2048x1536:
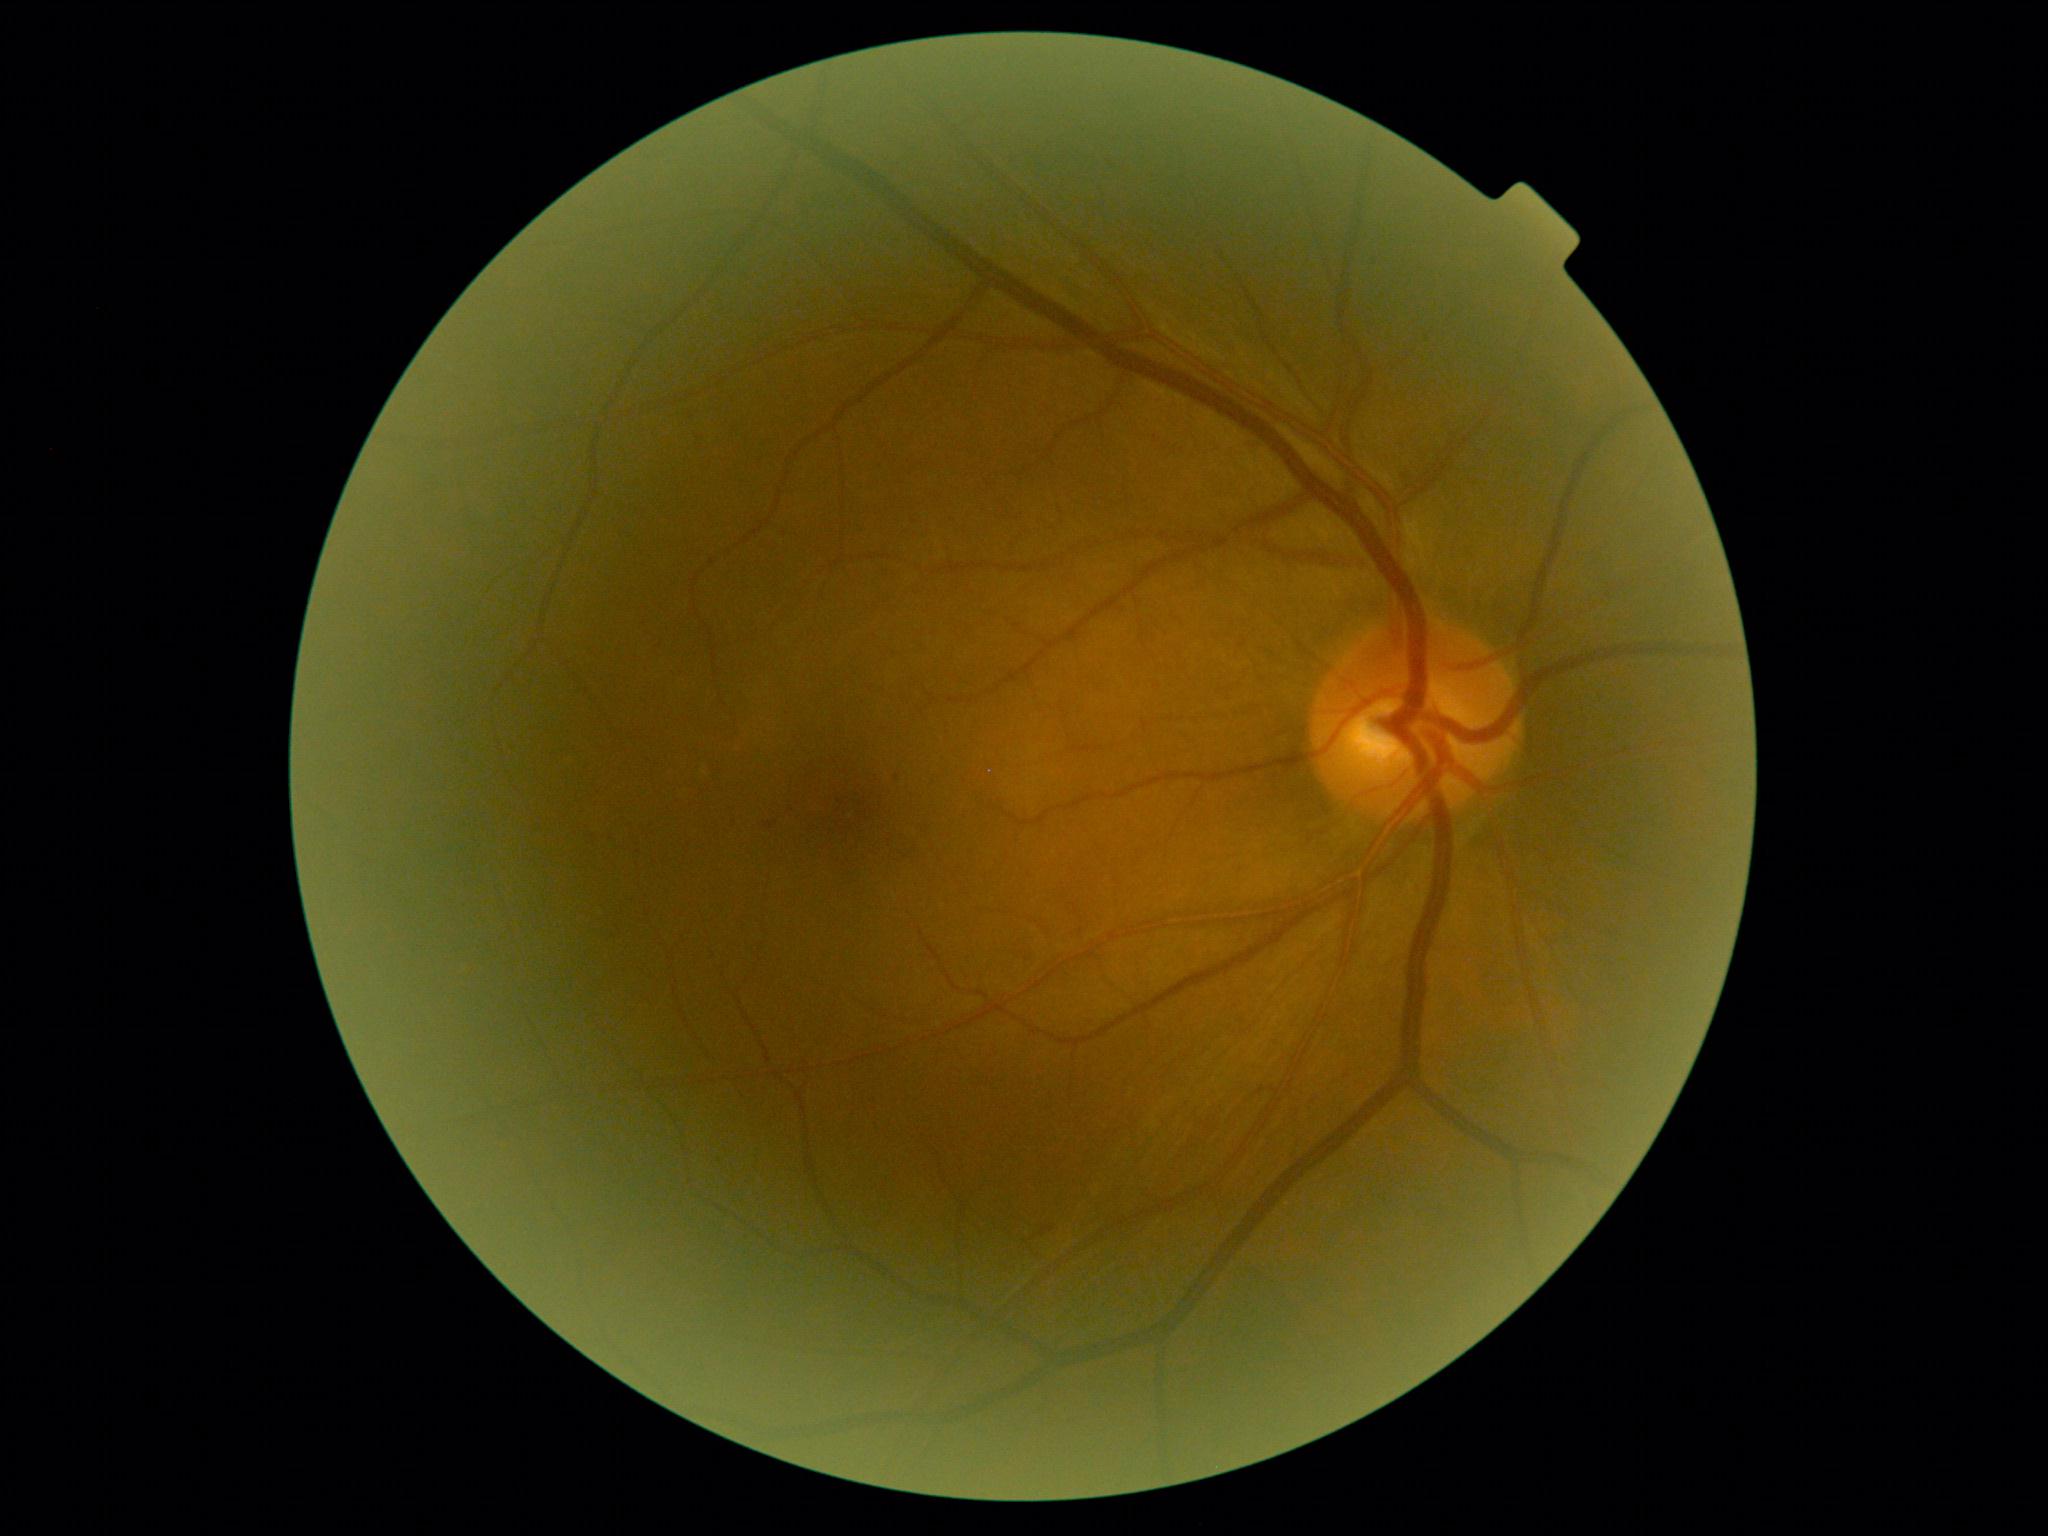 DR grade = 1.